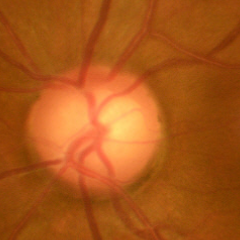

Glaucoma assessment: early glaucoma. Diagnostic criteria: glaucomatous retinal nerve fiber layer defects on red-free fundus photography without visual field defects.